CFP; no pharmacologic dilation; 45-degree field of view; modified Davis classification; NIDEK AFC-230; image size 848x848 — 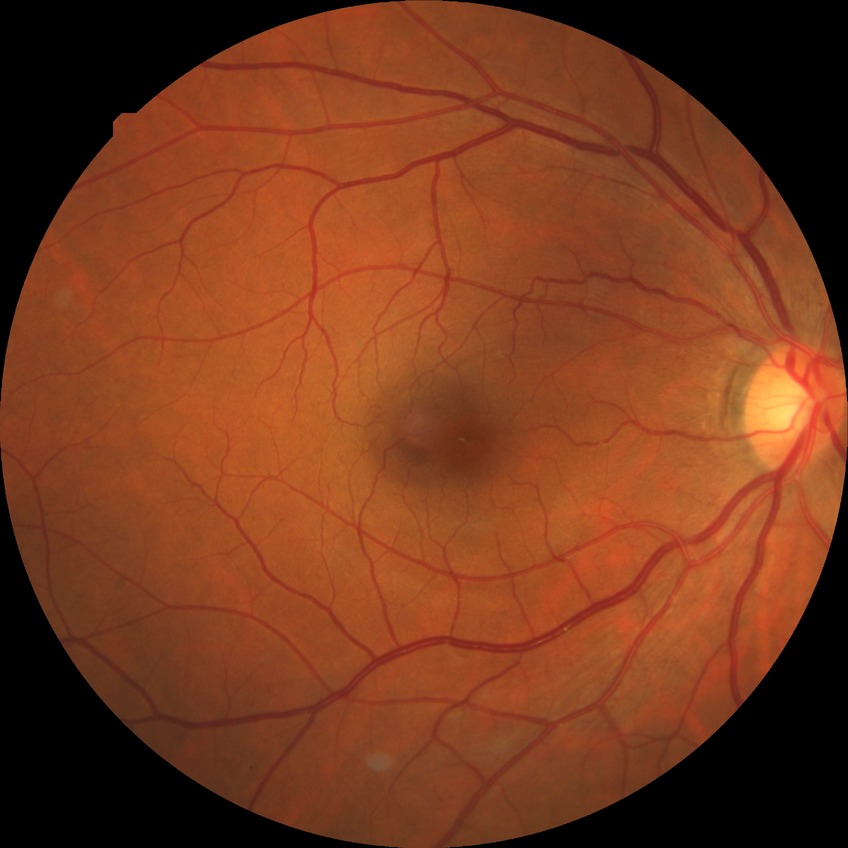

Diabetic retinopathy severity is simple diabetic retinopathy.